Image size 2089x1764. CFP — 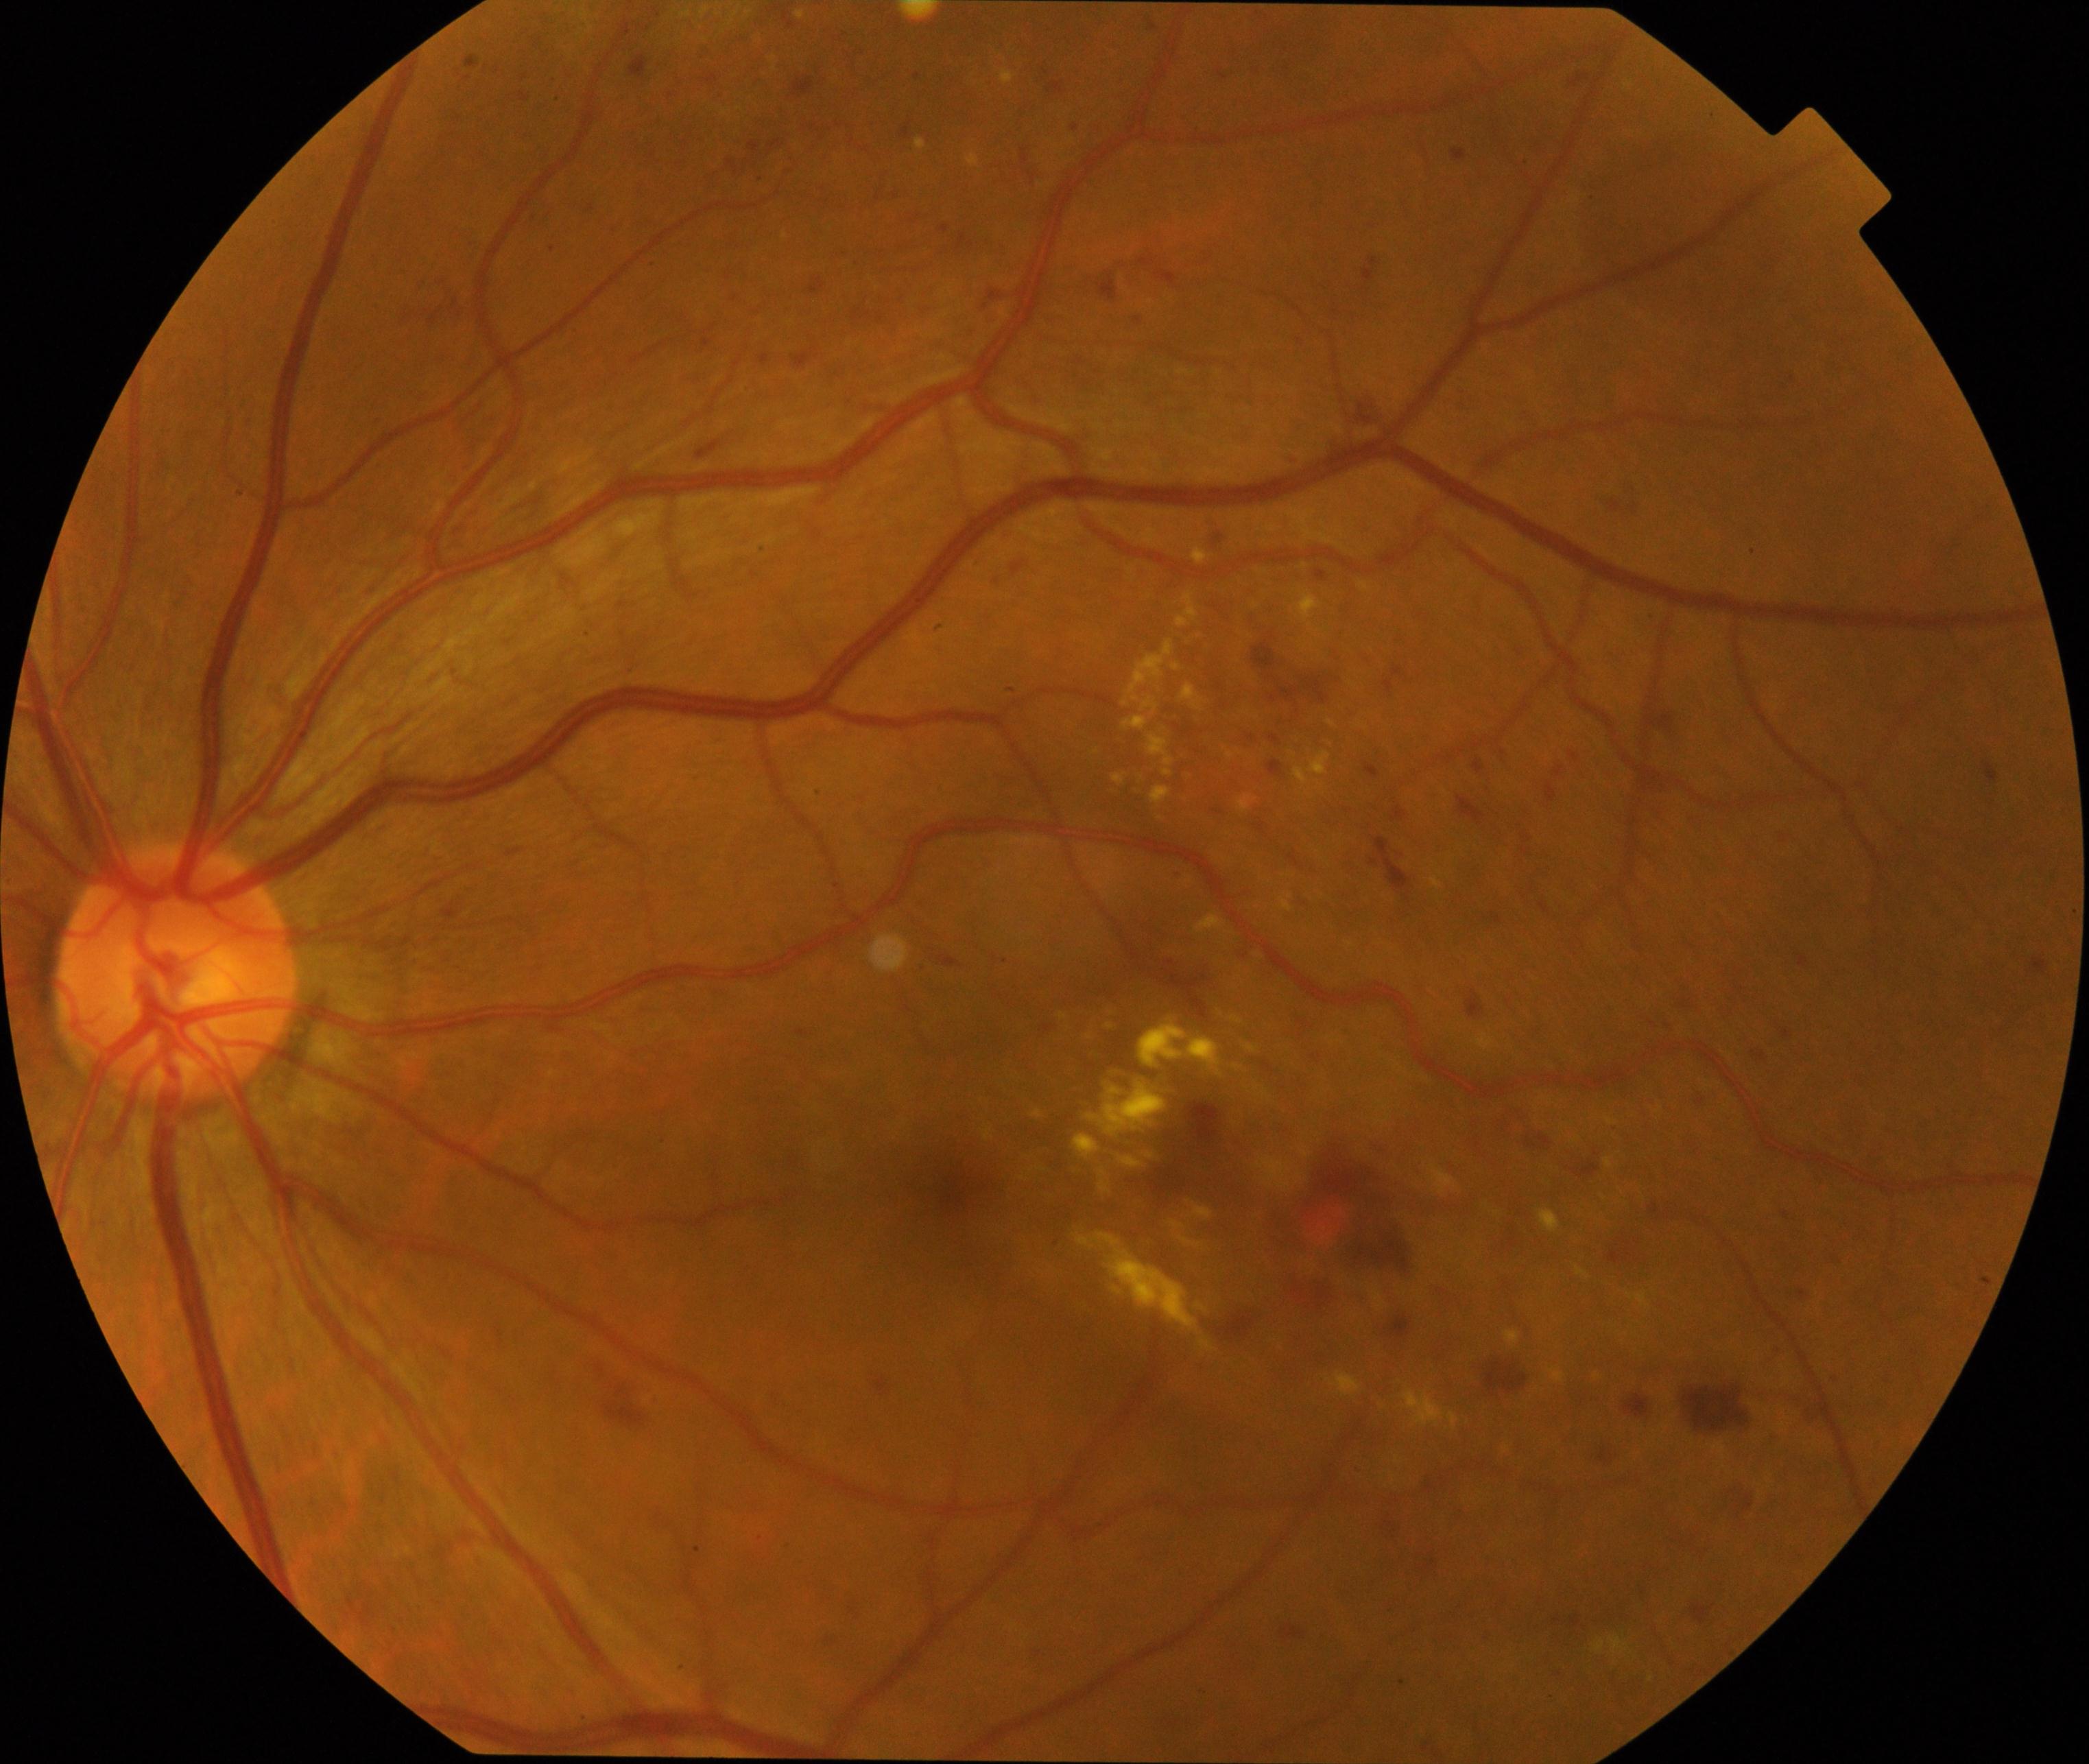

Classification: moderate non-proliferative diabetic retinopathy. Characterized by microaneurysms with dot and blot hemorrhages or hard exudates, less than severe non-proliferative diabetic retinopathy, and/or with diabetic macular edema.